Retinal fundus photograph; 45° FOV — 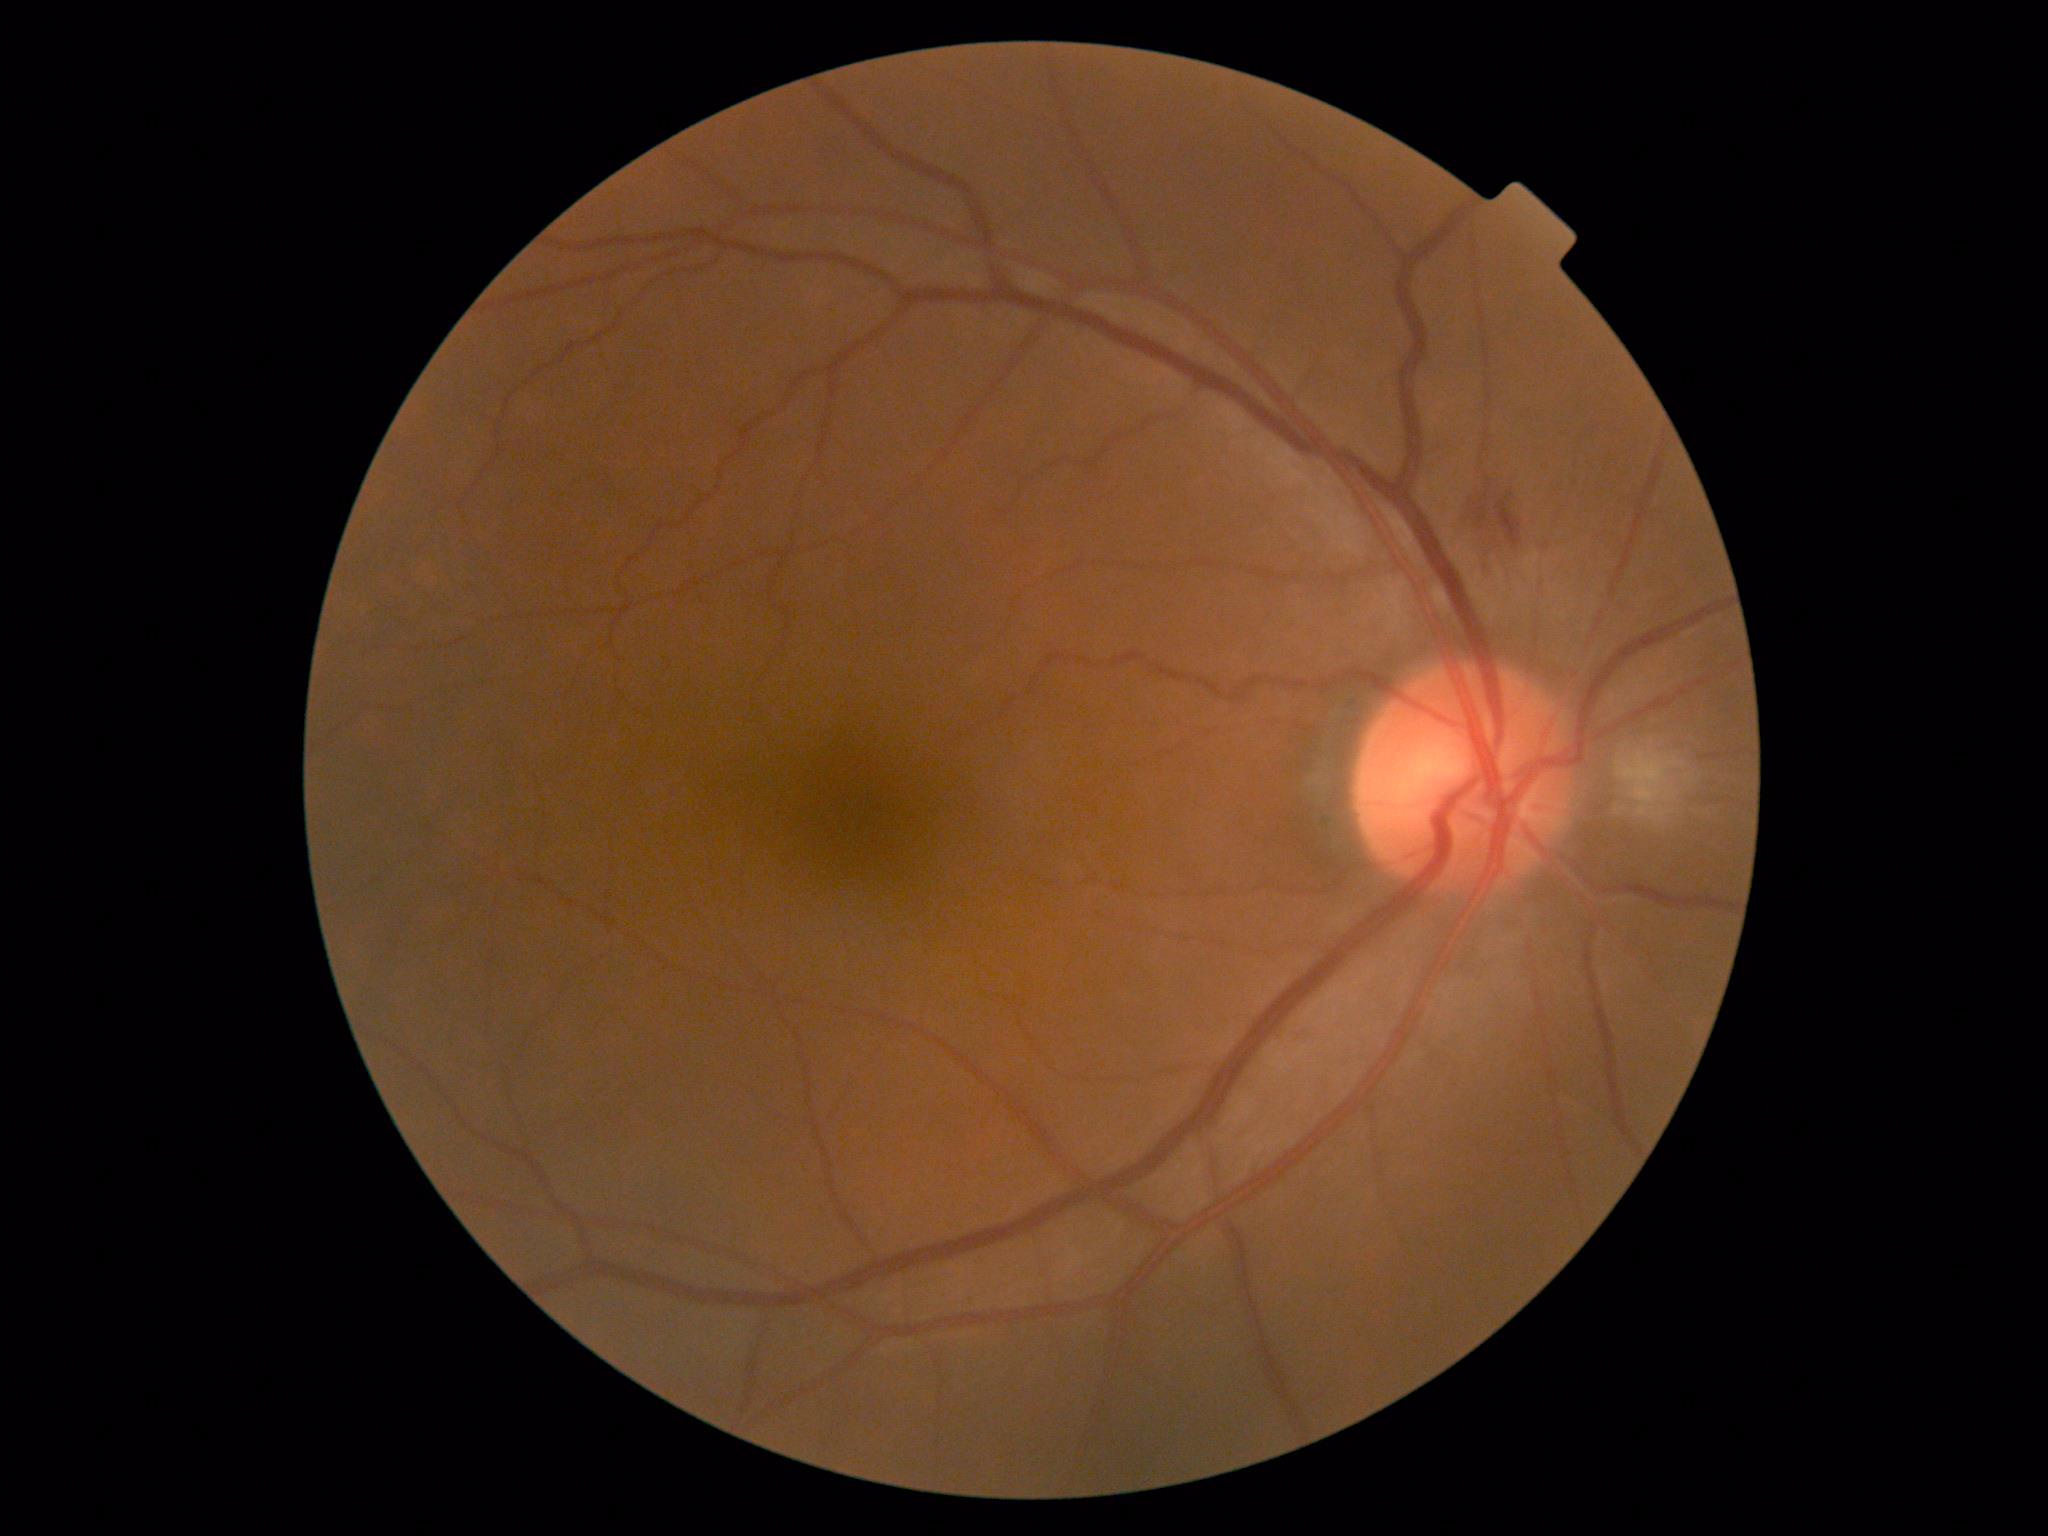

Retinopathy grade: 2.